Camera: Phoenix ICON (100° FOV). Wide-field fundus photograph from neonatal ROP screening: 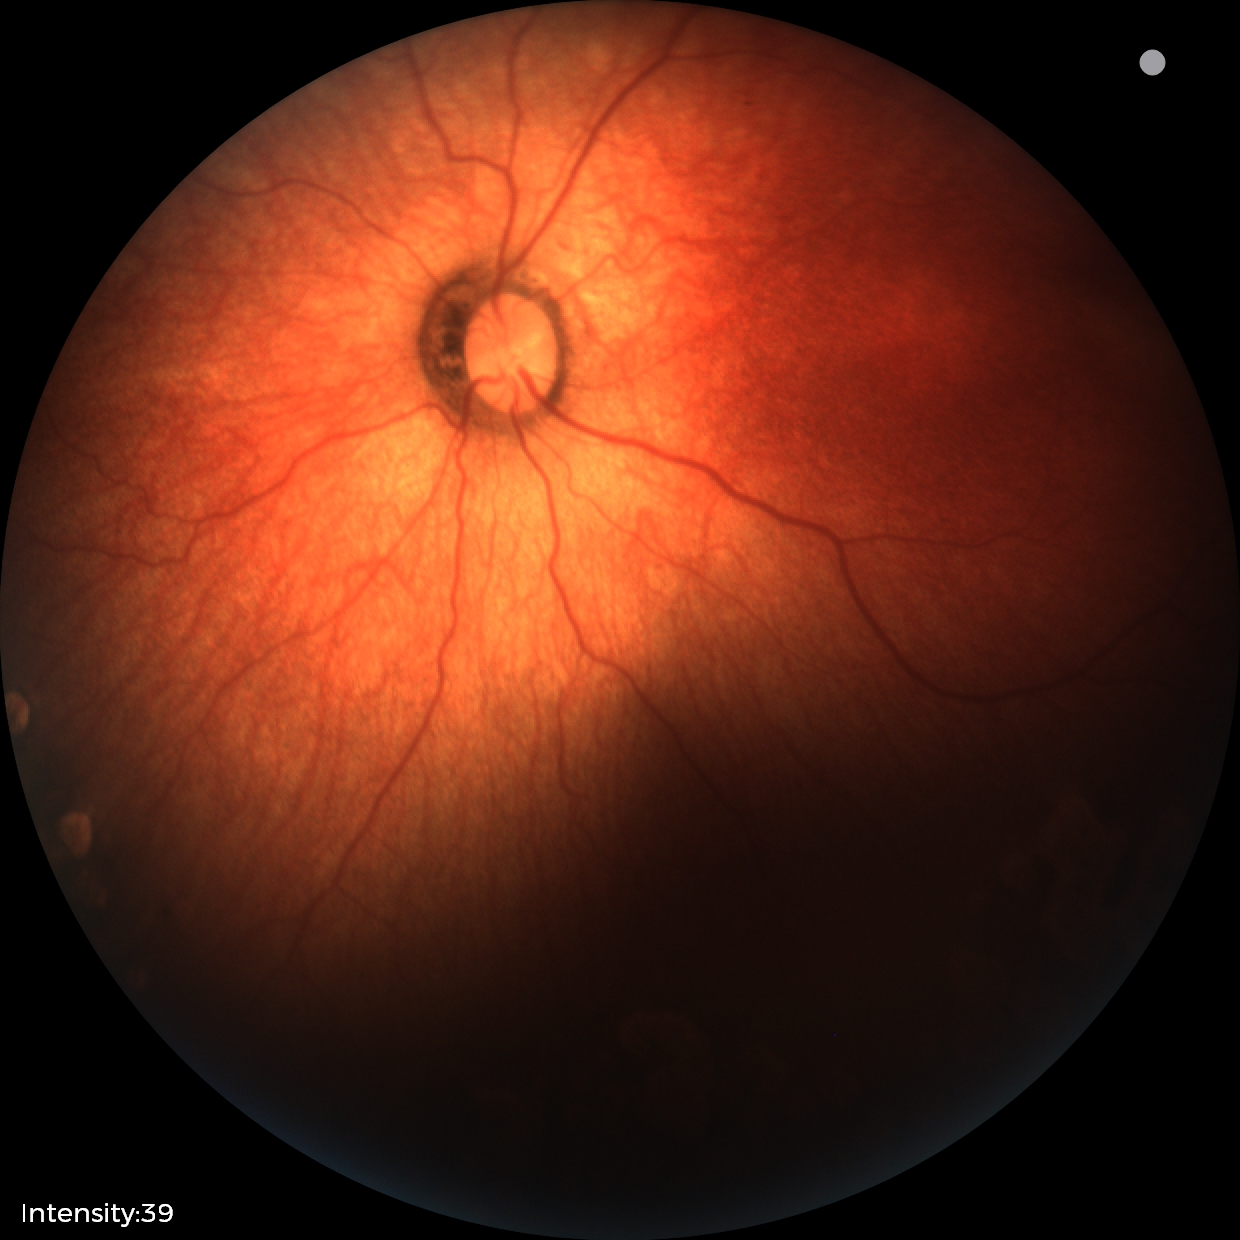 Diagnosis: status post ROP.